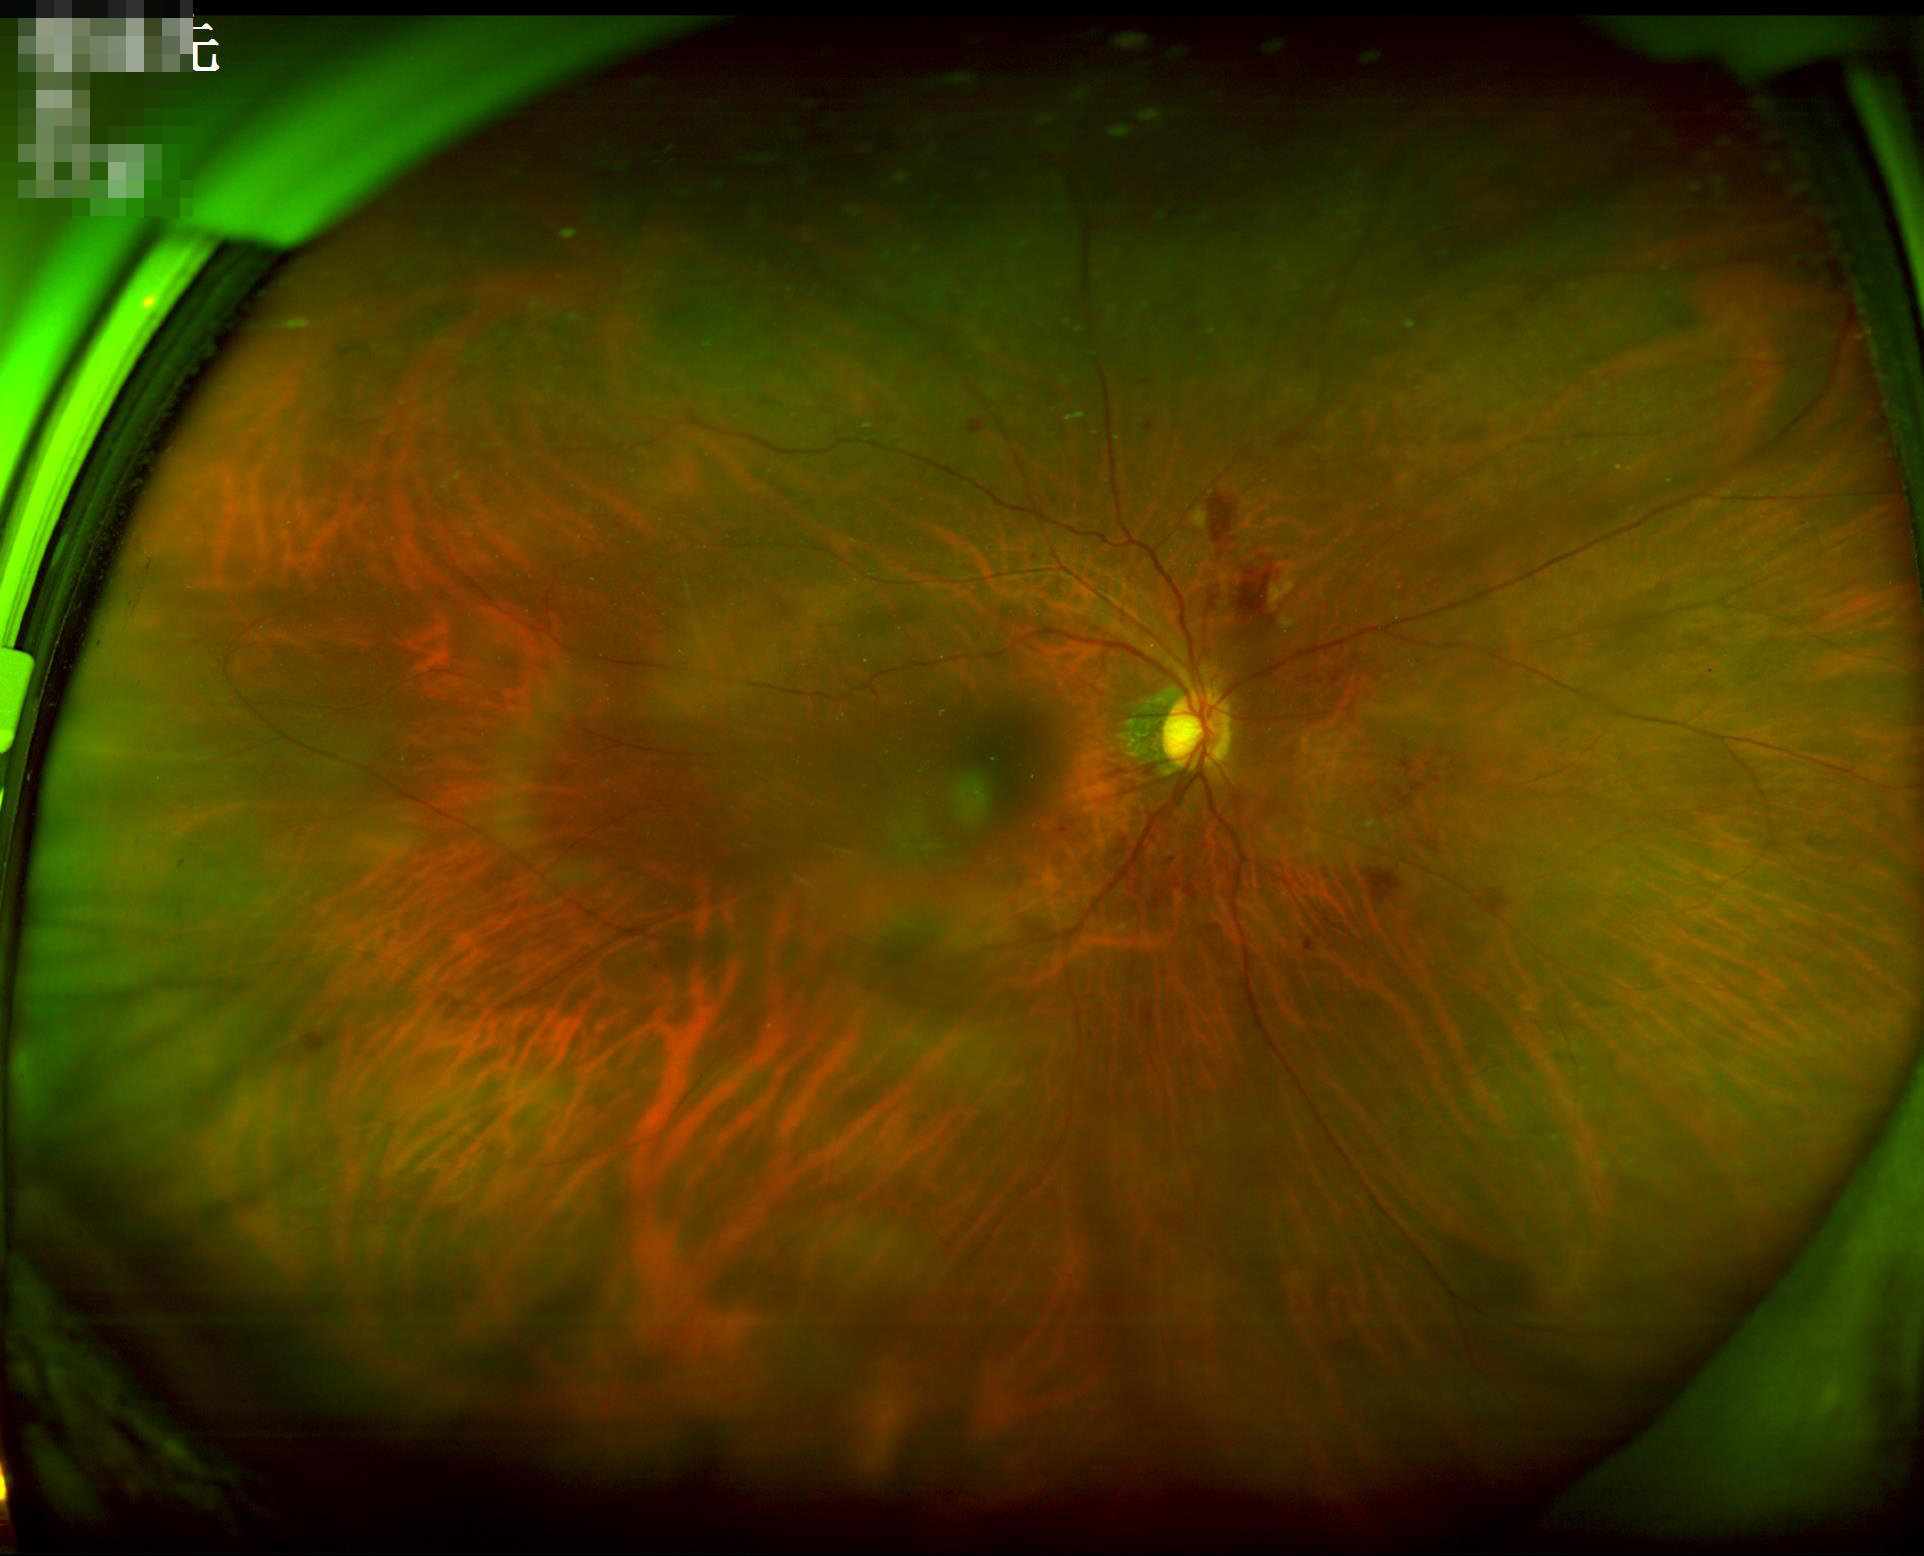
Image quality is inadequate for diagnostic use. Noticeable blur in the optic disc, vessels, or background. No over- or under-exposure.